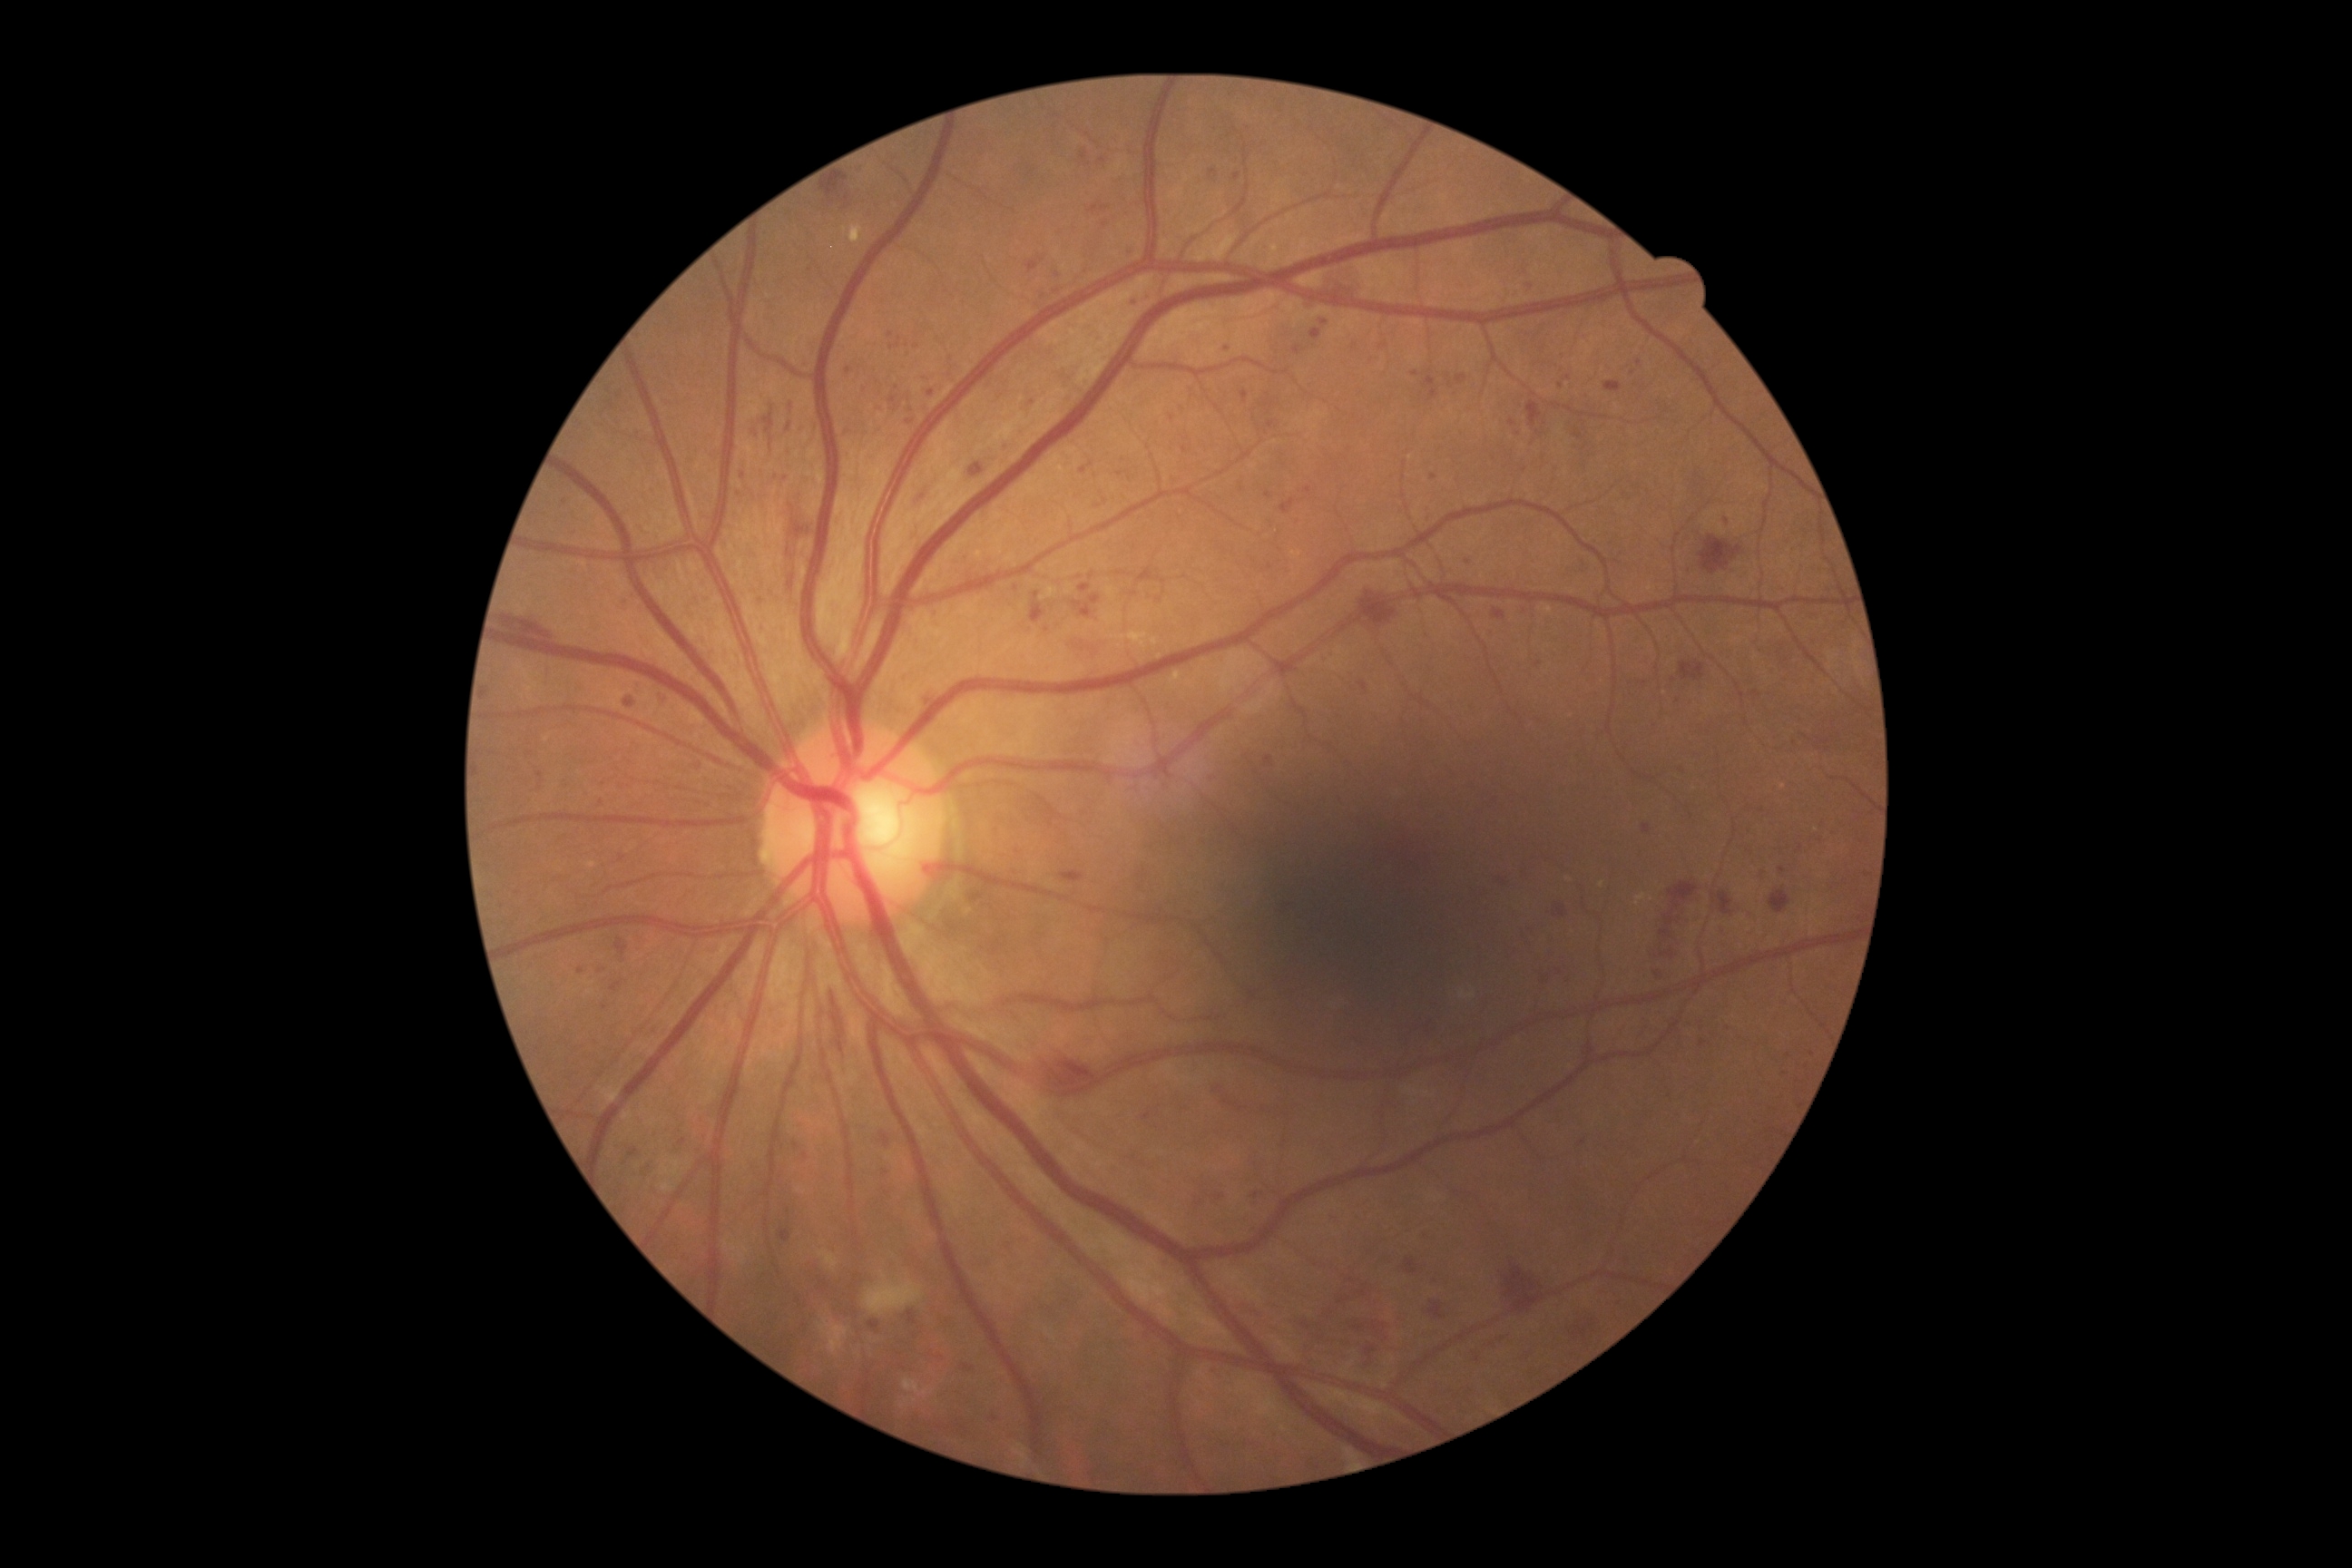
Diabetic retinopathy severity: 3/4 — more than 20 intraretinal hemorrhages in each of 4 quadrants, definite venous beading in 2 or more quadrants, or prominent intraretinal microvascular abnormalities in 1 or more quadrants, with no signs of proliferative retinopathy
A subset of detected lesions:
microaneurysms (partial): <box>1081,152,1088,161</box> | <box>750,427,761,440</box> | <box>1224,1101,1235,1106</box> | <box>625,700,636,709</box> | <box>558,498,567,504</box> | <box>1211,1369,1217,1377</box> | <box>901,393,912,404</box> | <box>1574,431,1583,440</box> | <box>1280,500,1295,514</box>
Additional small microaneurysms near 1200:1204 | 1268:495 | 581:971 | 1016:589 | 1703:1043 | 1468:563 | 1782:869 | 601:803 | 891:335